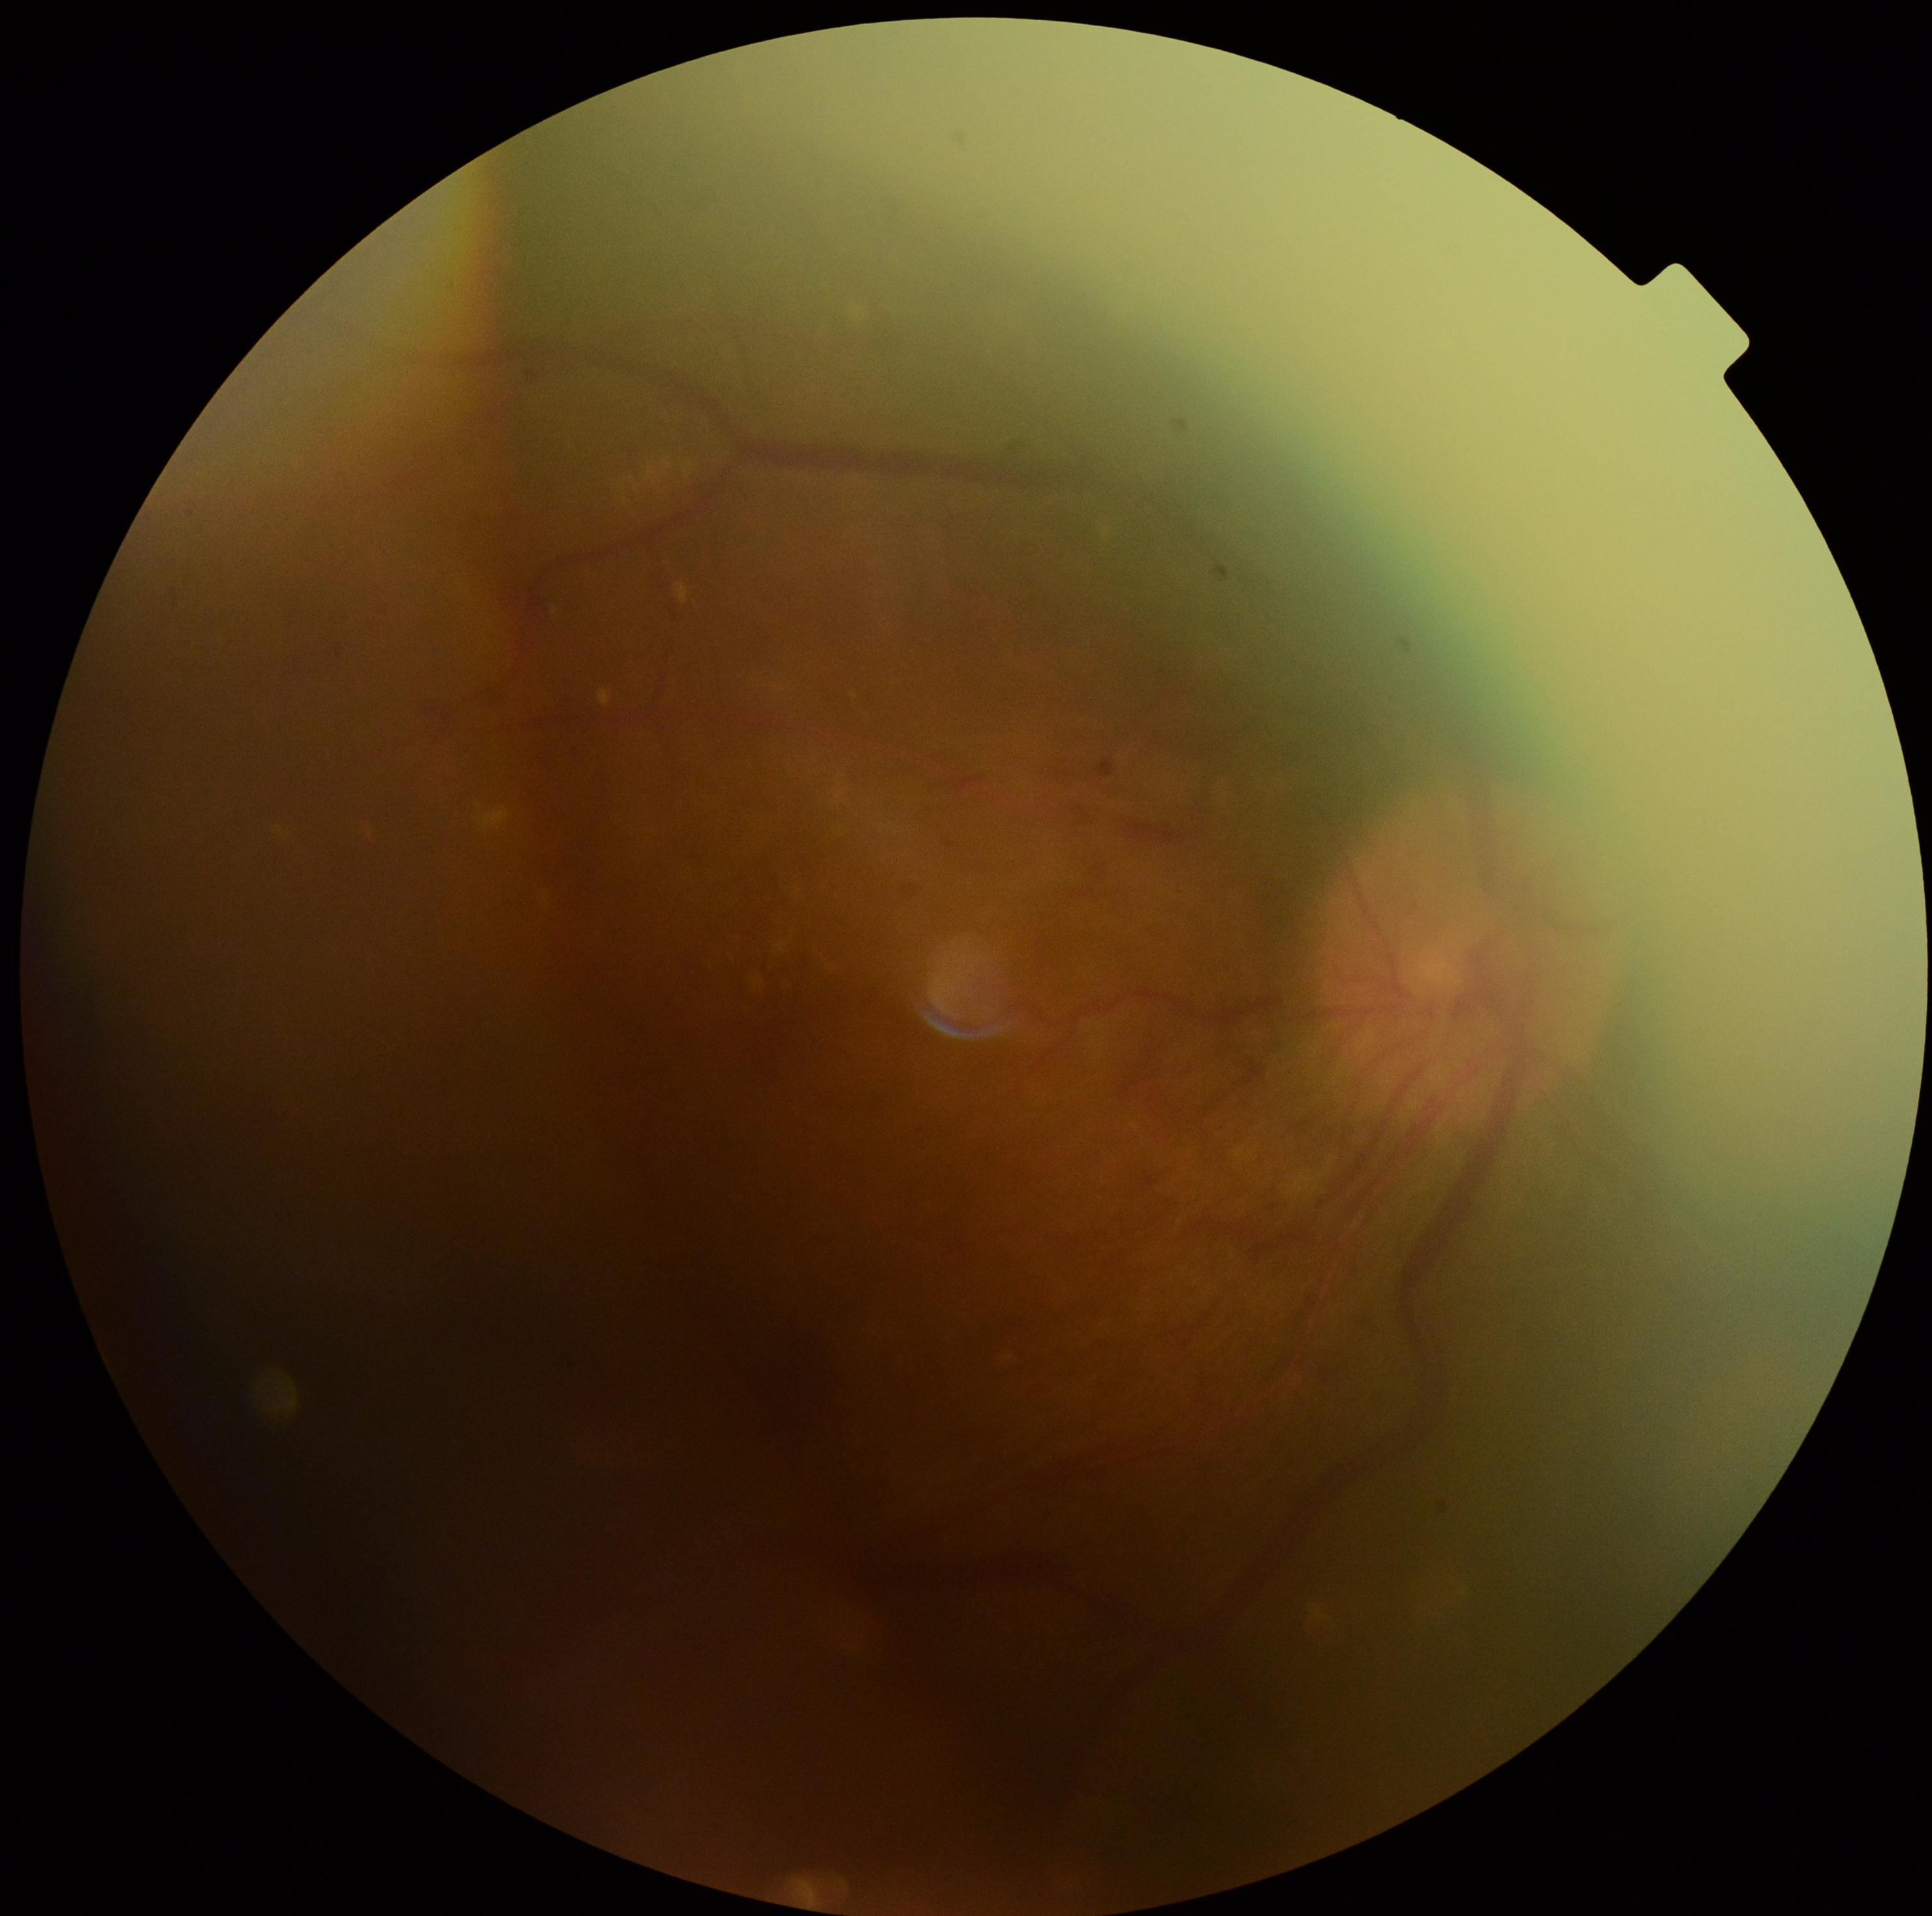

Retinopathy grade is 4 (PDR).